2212 by 1659 pixels: 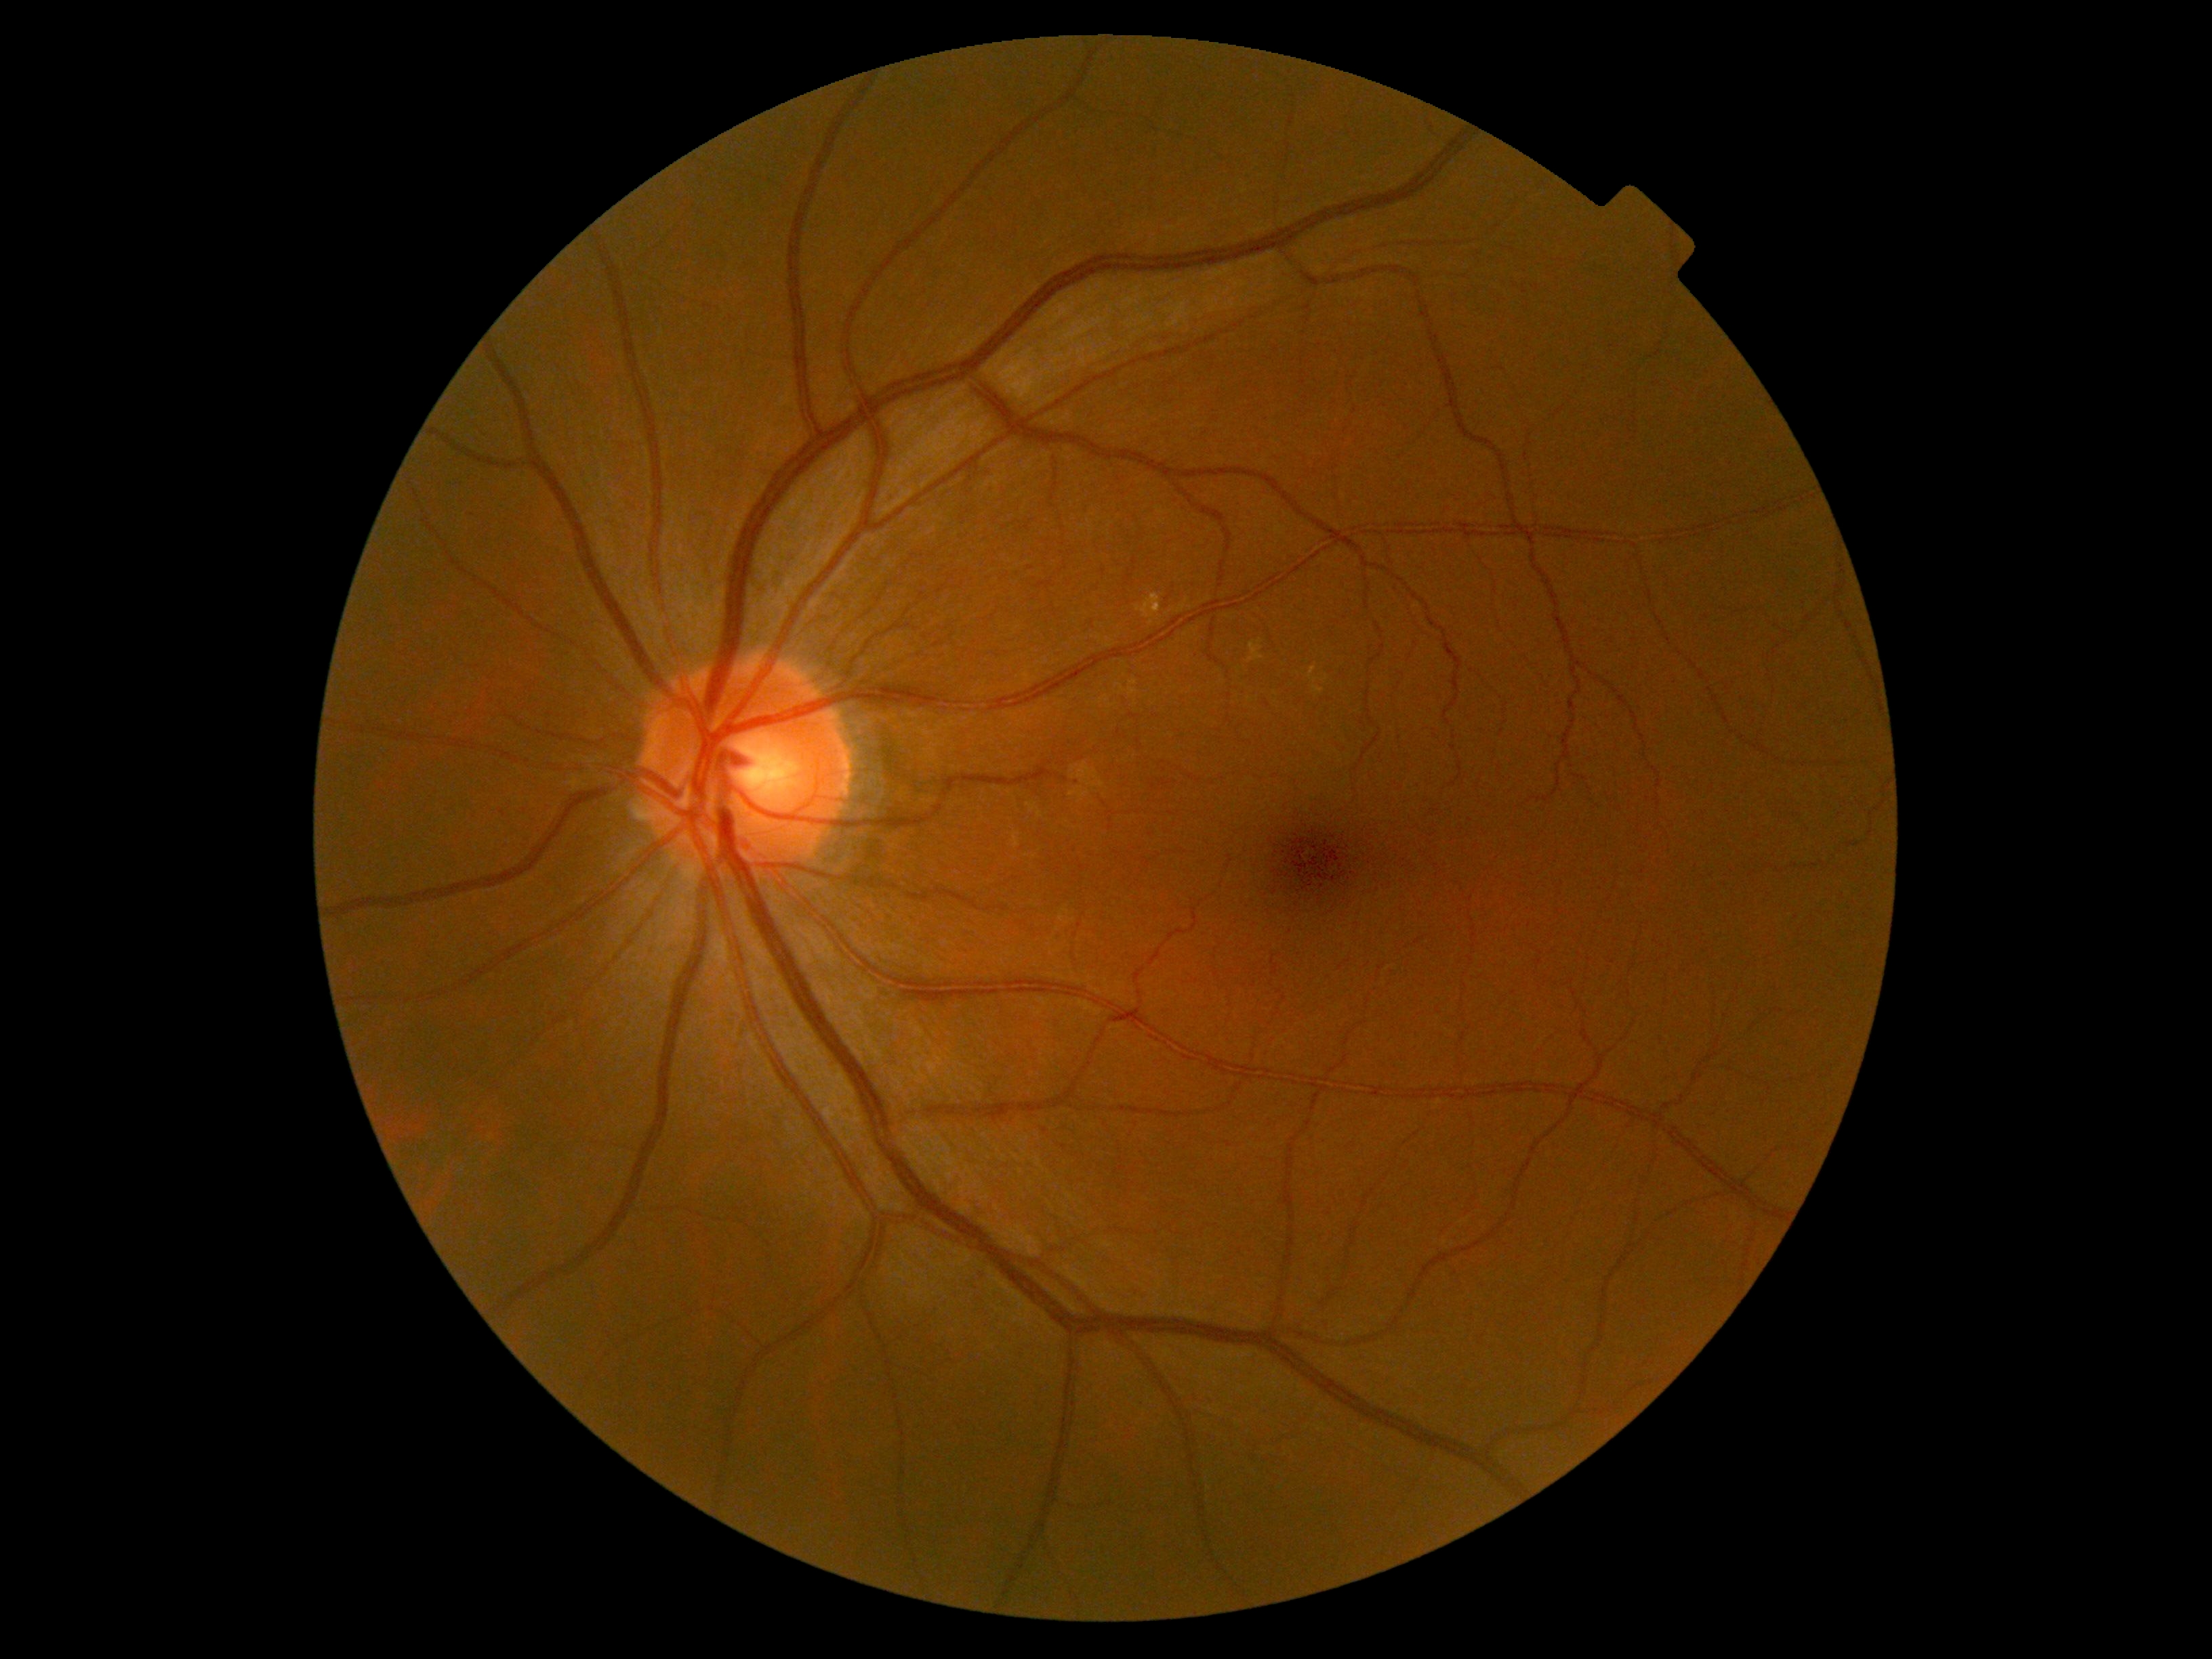
Findings:
* DR stage: no apparent retinopathy (grade 0)